No pharmacologic dilation — 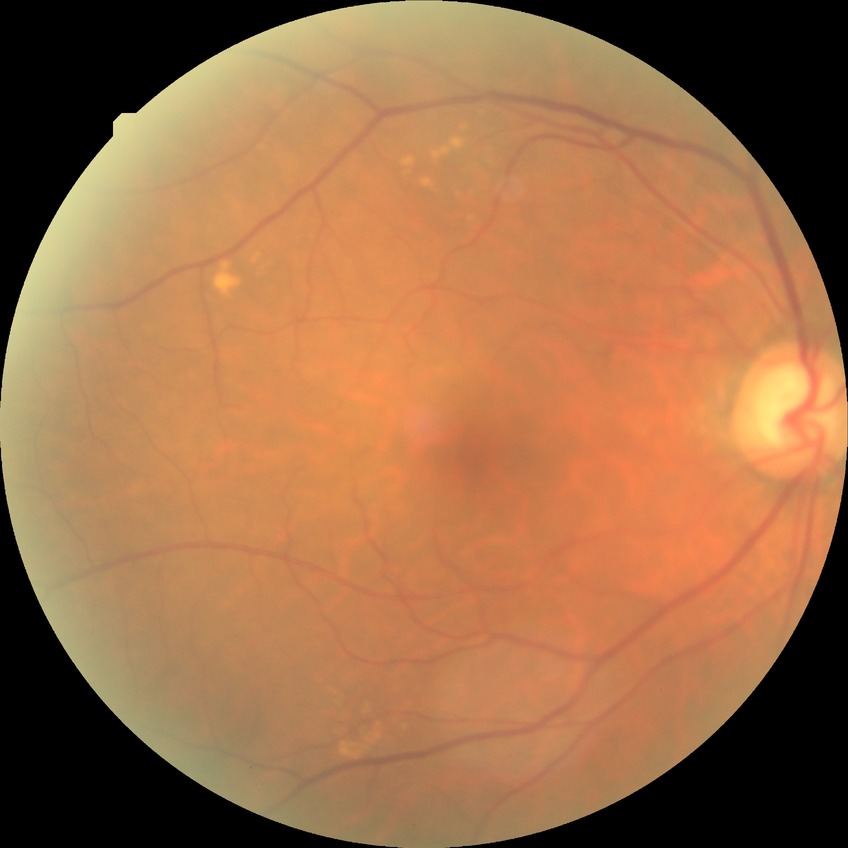
Davis stage is NDR.
No apparent diabetic retinopathy.